Color fundus photograph:
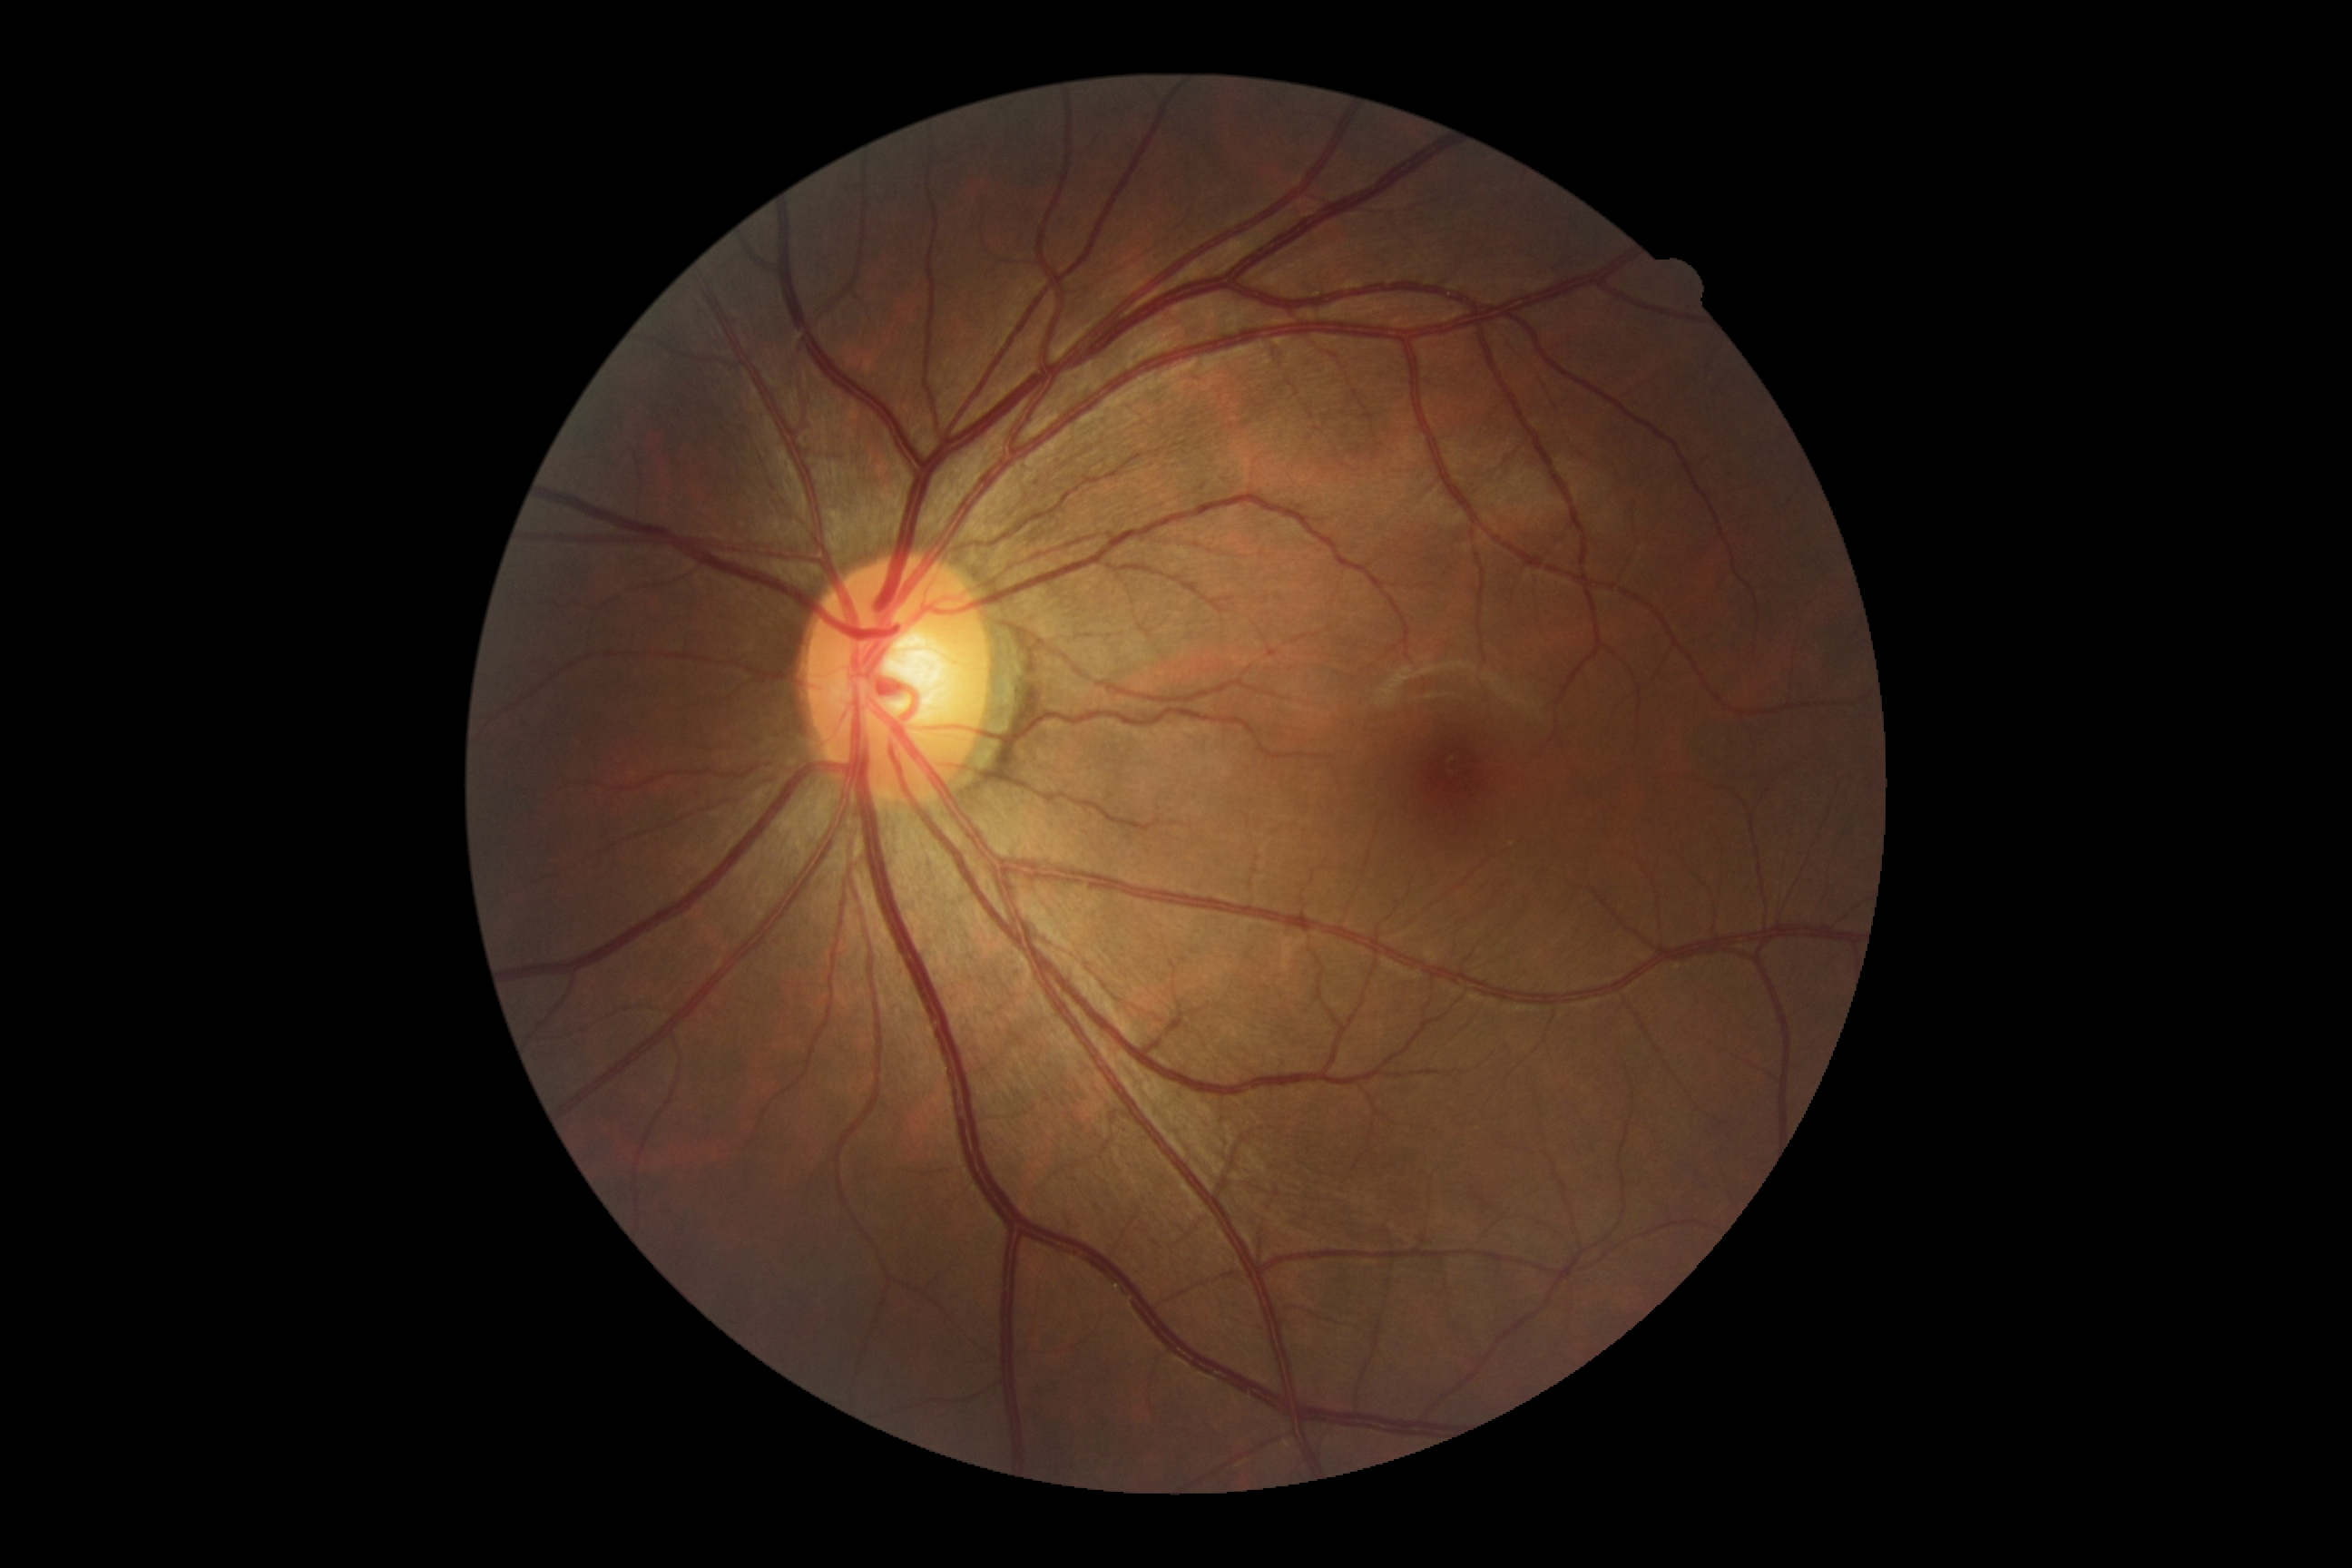
– DR impression — no apparent DR
– diabetic retinopathy (DR) — grade 0 — no visible signs of diabetic retinopathy